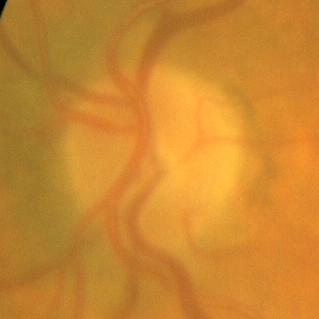

Q: Is there glaucomatous optic neuropathy?
A: No — no evidence of glaucoma.